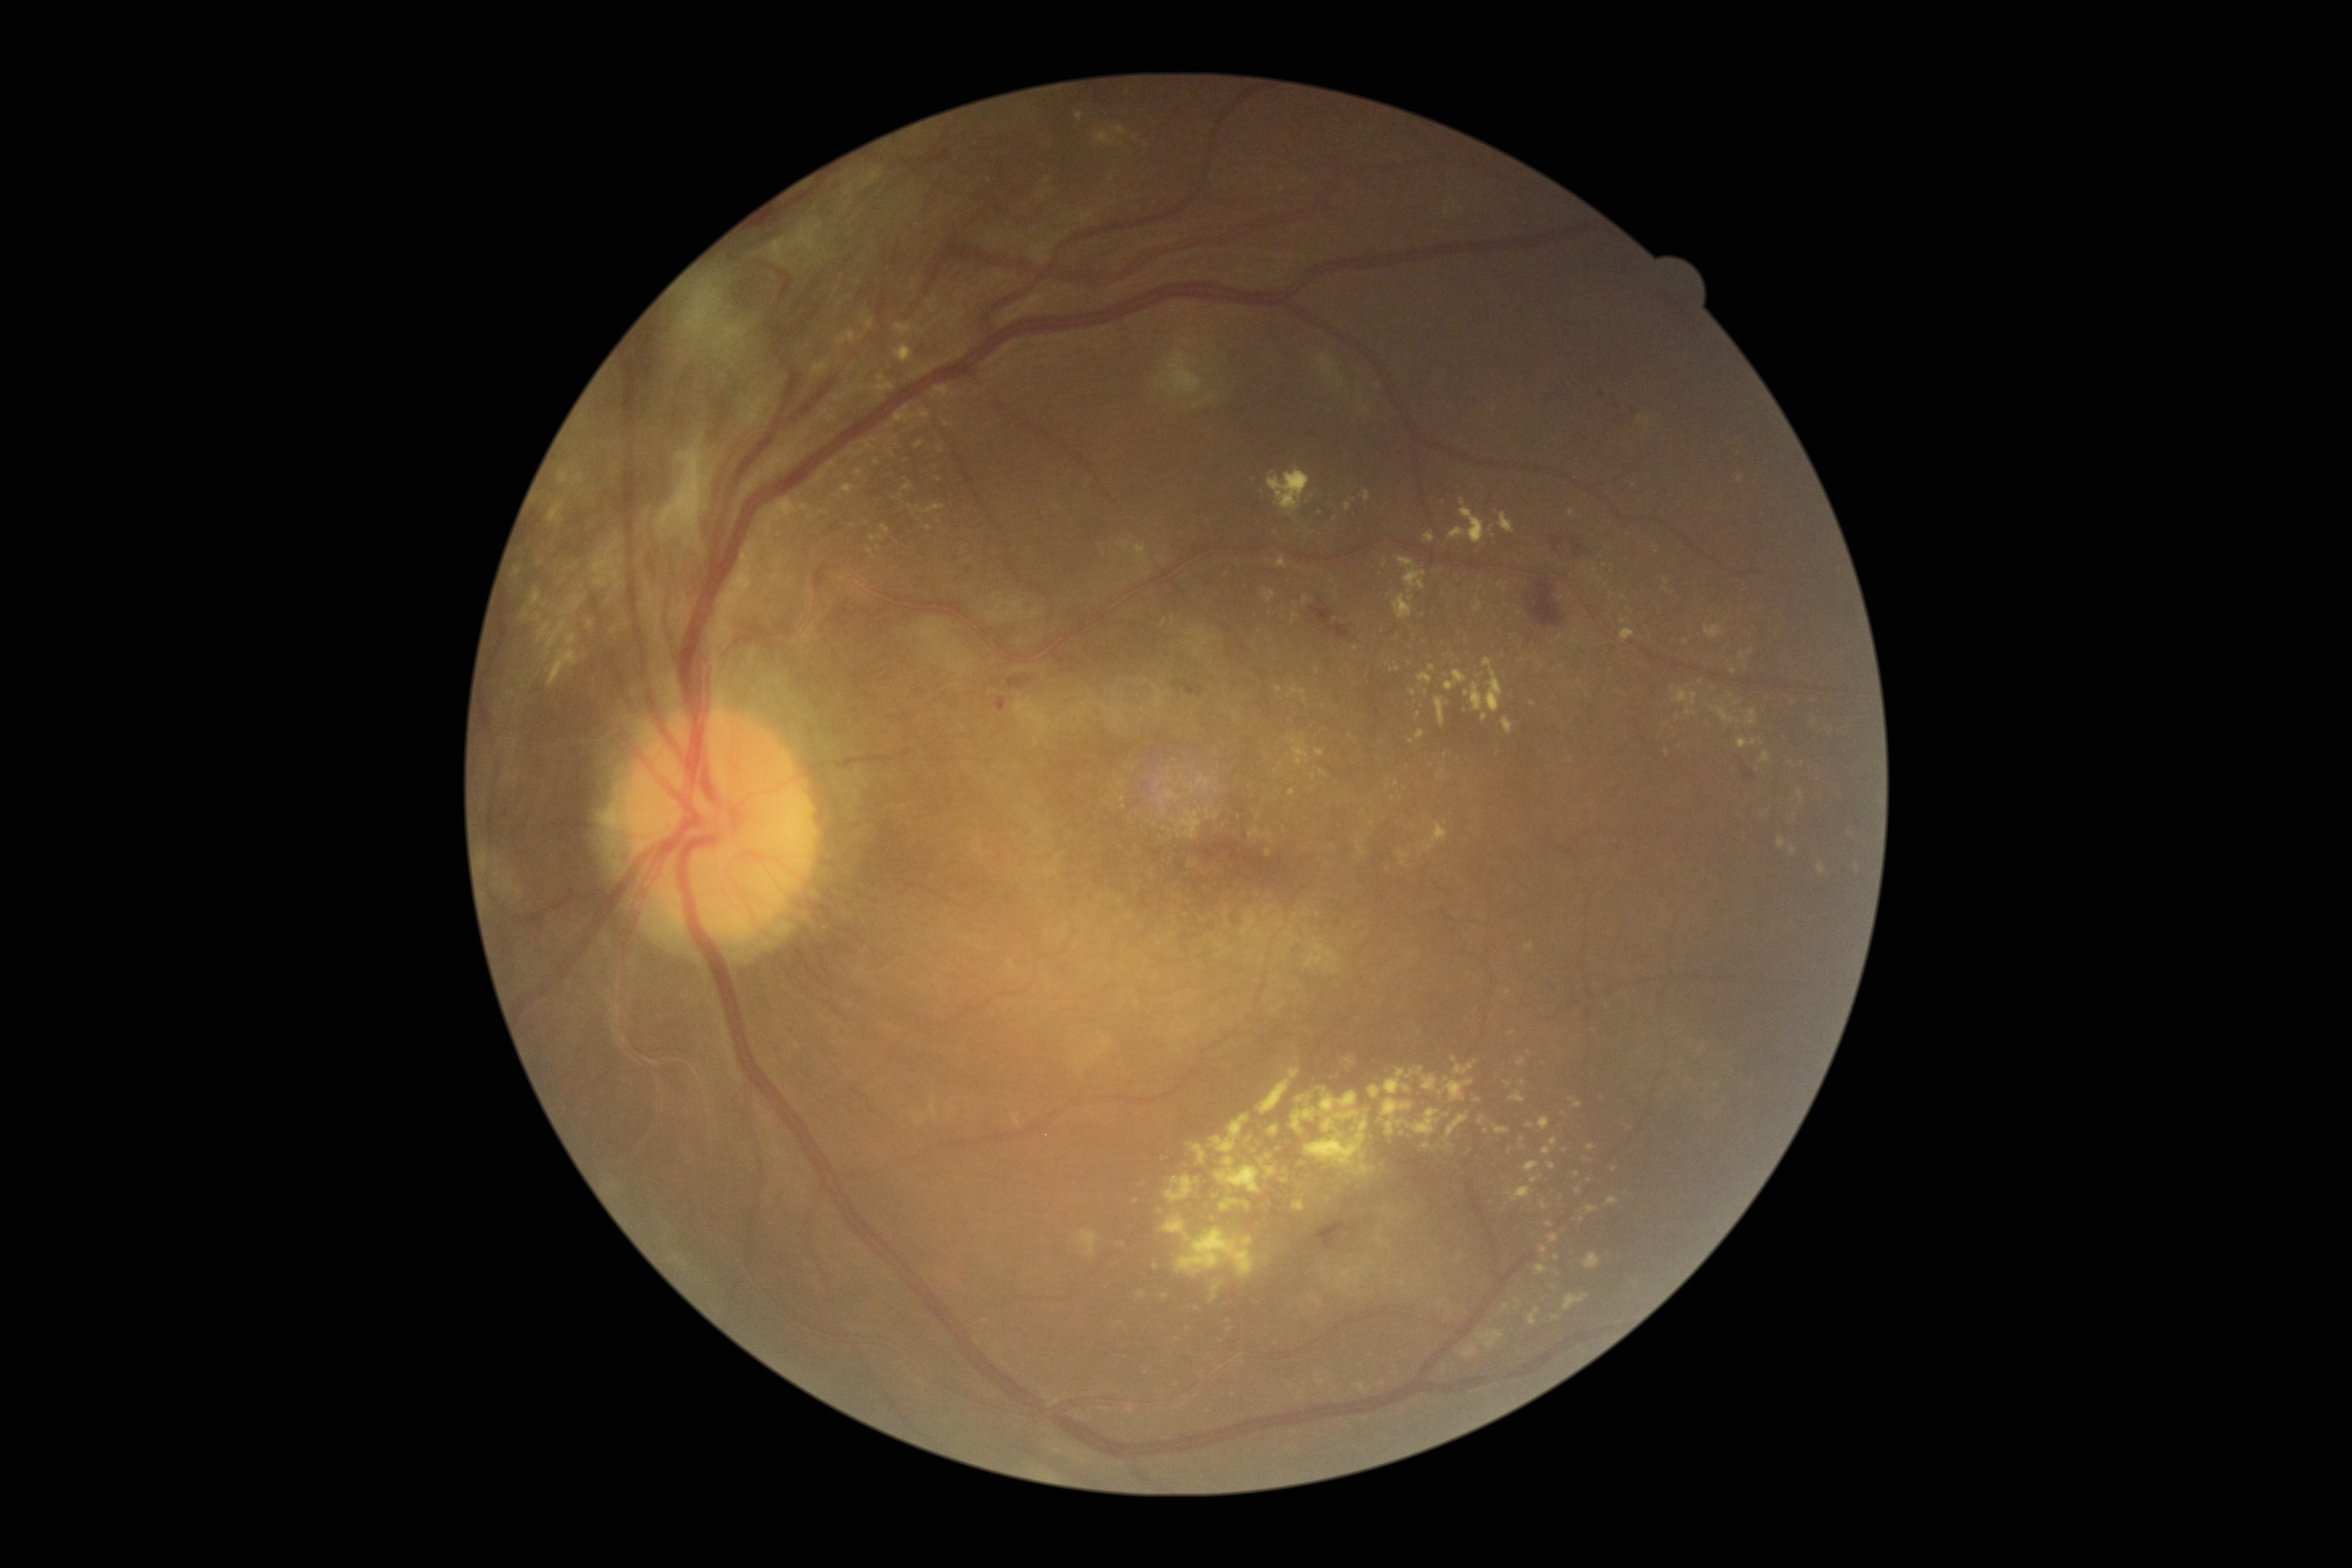 Diabetic retinopathy (DR) is 4/4; proliferative diabetic retinopathy. Hard exudates (EXs) include lesions at <bbox>518, 610, 529, 620</bbox>, <bbox>1541, 1246, 1548, 1255</bbox>, <bbox>1305, 1116, 1368, 1168</bbox>, <bbox>1077, 1229, 1099, 1258</bbox>, <bbox>1664, 748, 1669, 756</bbox>, <bbox>871, 436, 881, 443</bbox>, <bbox>895, 343, 914, 362</bbox>, <bbox>1406, 1071, 1414, 1079</bbox>, <bbox>1399, 851, 1410, 867</bbox>, <bbox>1220, 1197, 1240, 1210</bbox>, <bbox>1495, 1126, 1511, 1134</bbox>, <bbox>1165, 1175, 1200, 1202</bbox>. Small EXs approximately at <point>1581, 1218</point>, <point>1413, 693</point>, <point>1308, 761</point>, <point>1858, 866</point>, <point>1351, 736</point>, <point>518, 575</point>, <point>1355, 647</point>, <point>1269, 1156</point>.